Wide-field contact fundus photograph of an infant. 640 by 480 pixels: 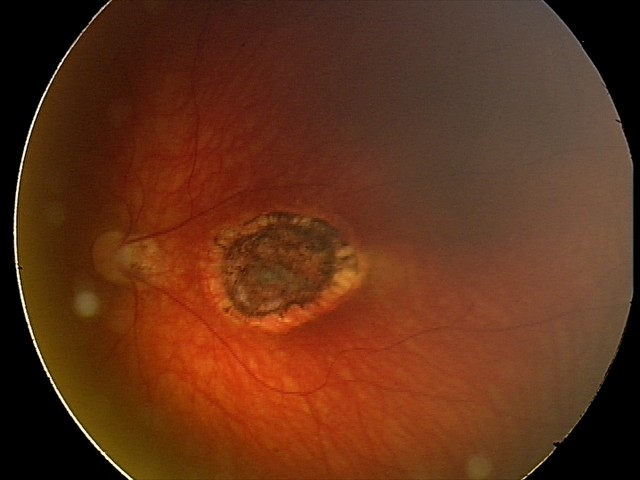 Screening series with toxoplasmosis chorioretinitis.